45-degree field of view · color fundus image · 2352 by 1568 pixels:
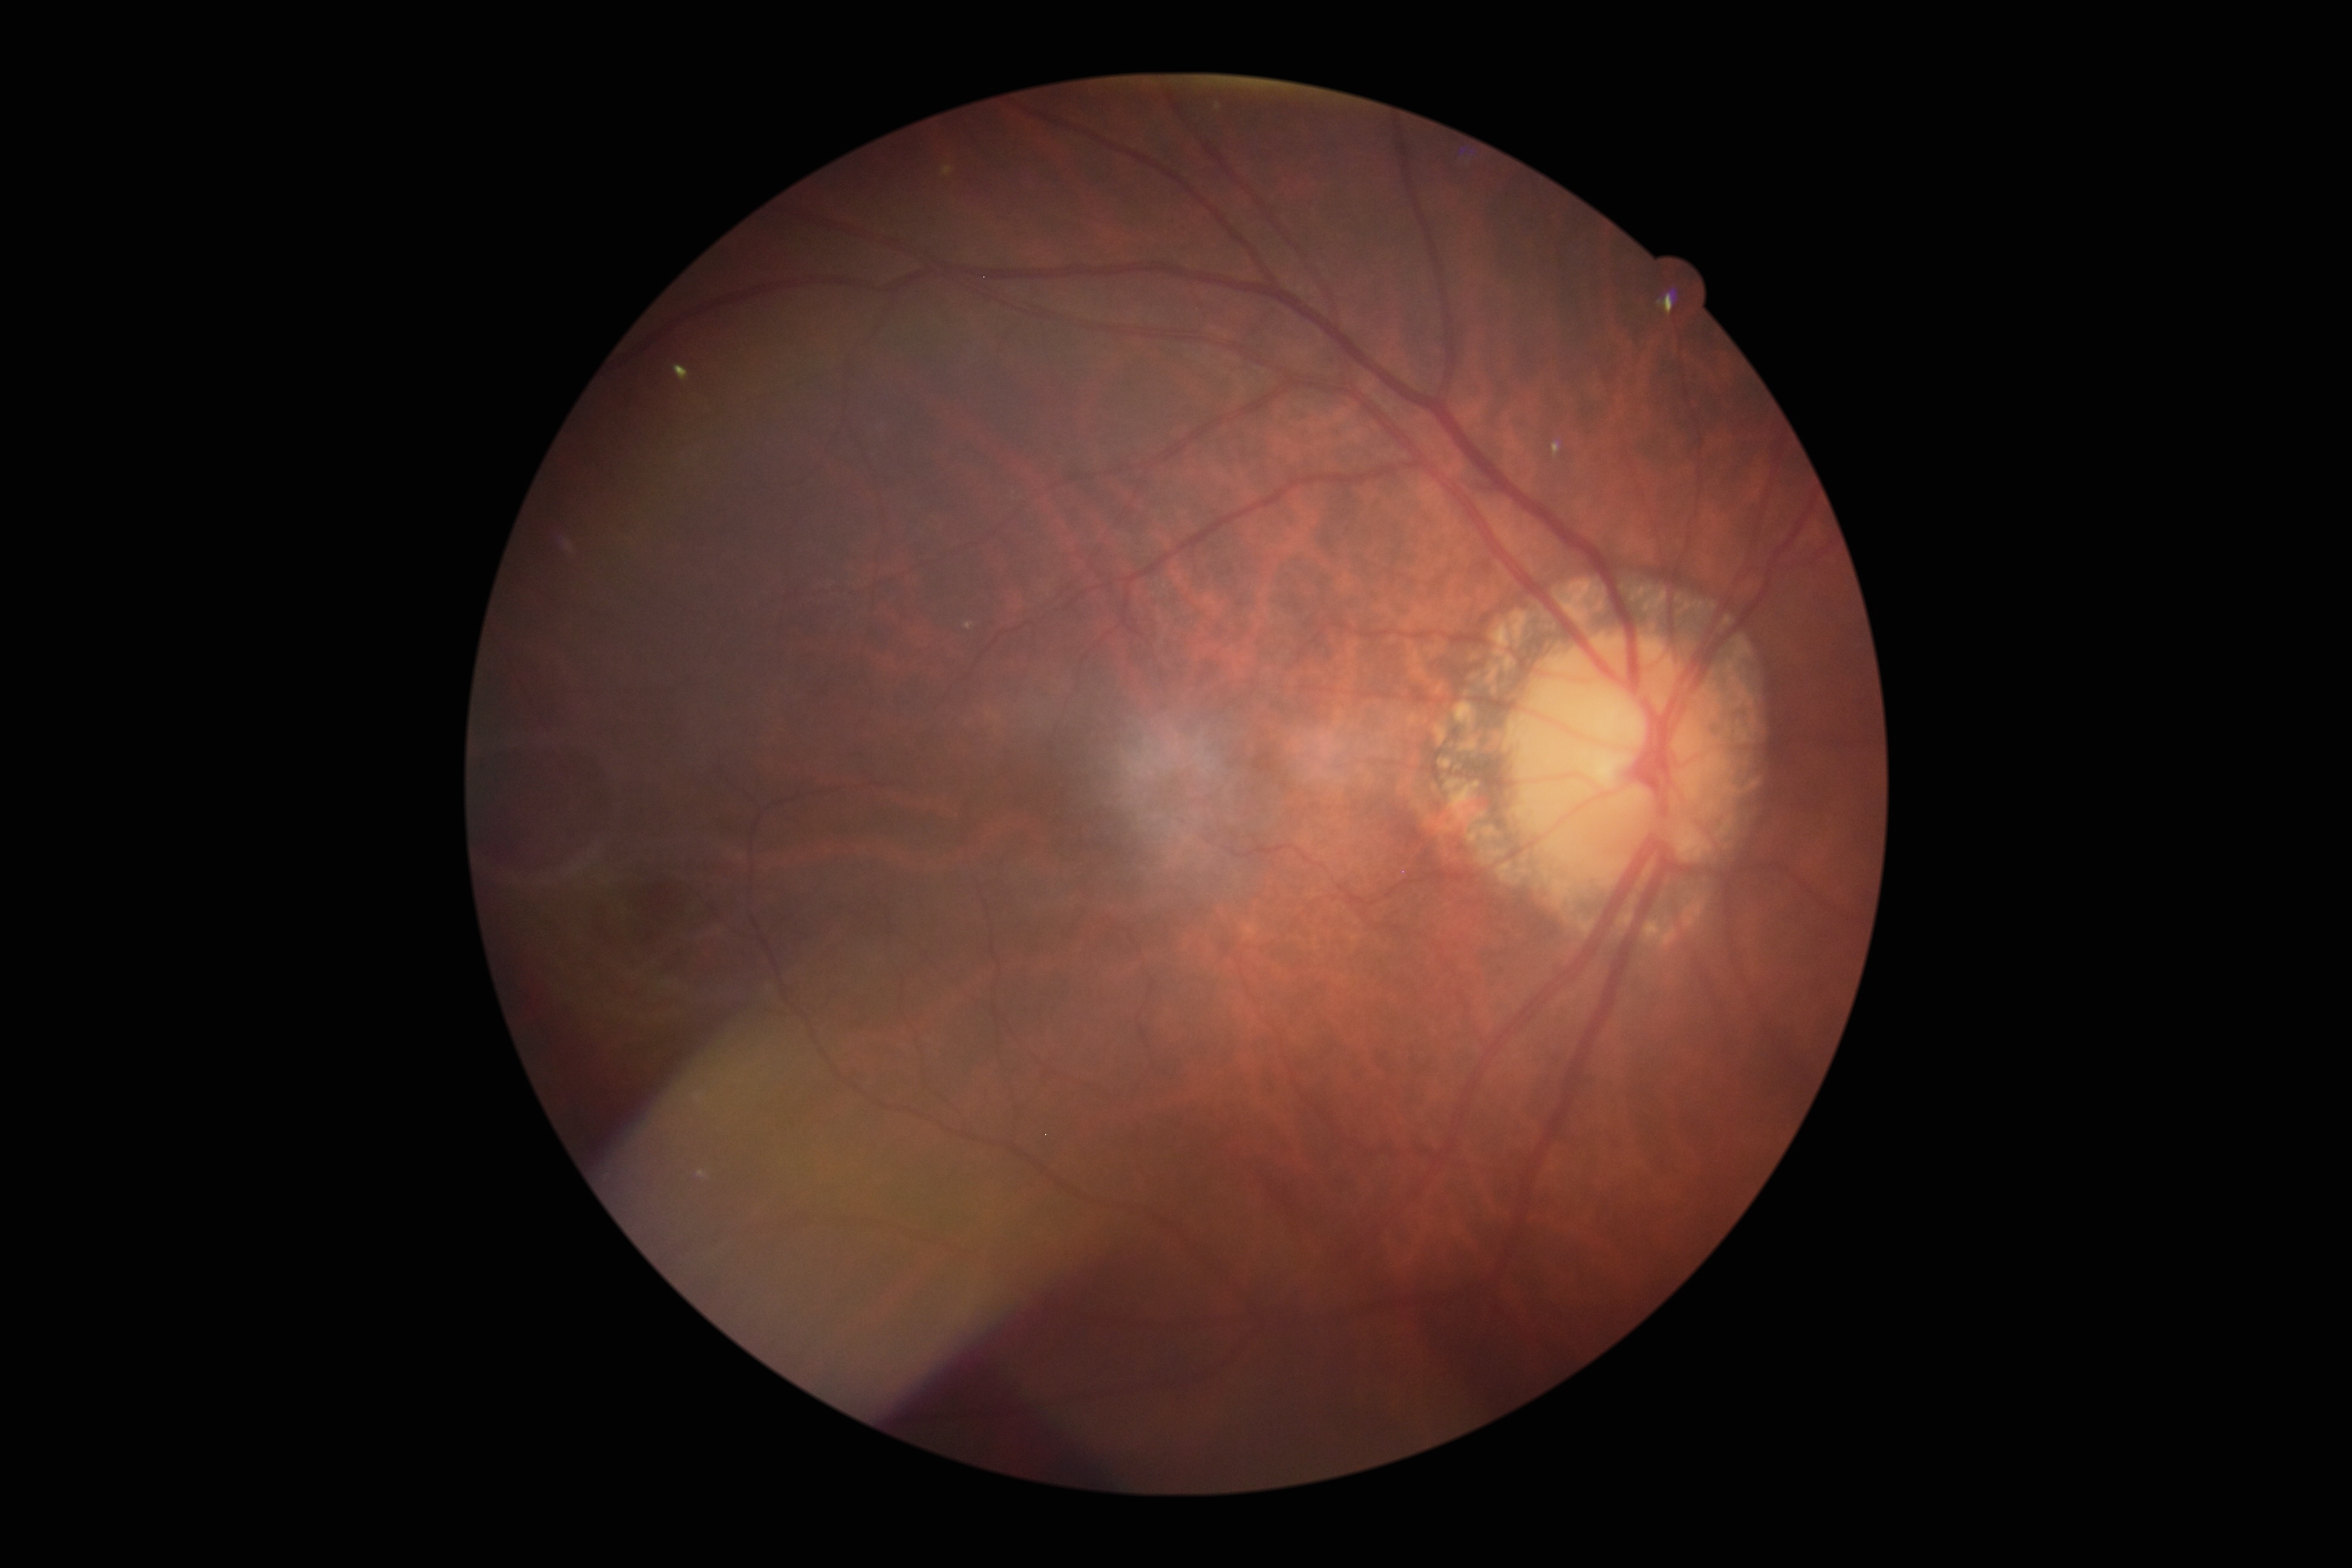

Diabetic retinopathy: grade 0.